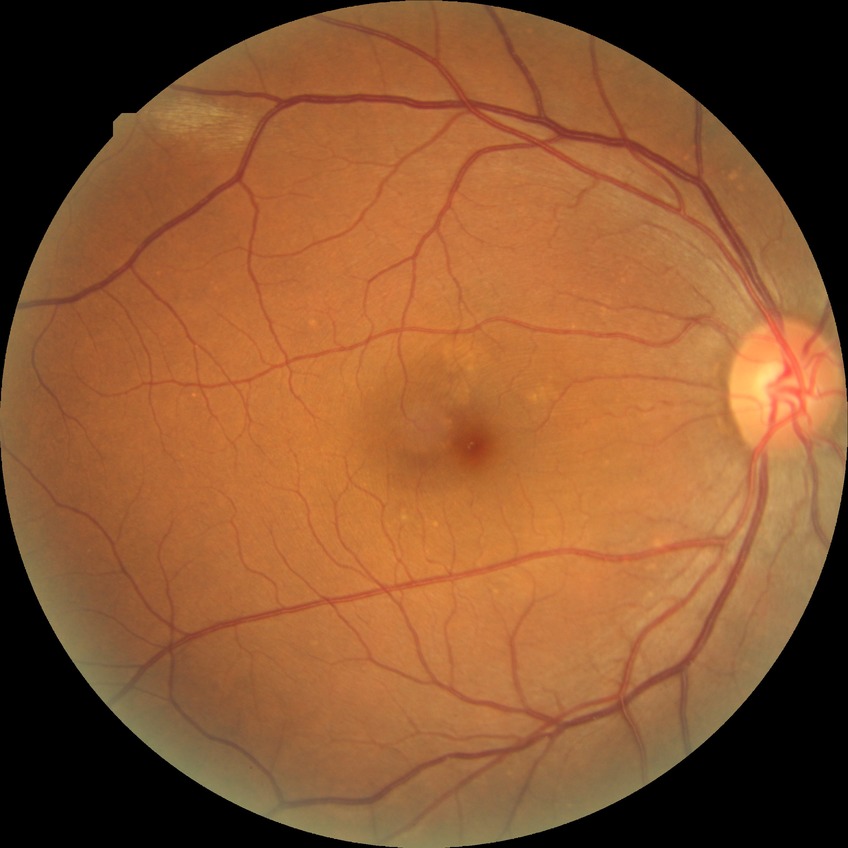
{
  "davis_grade": "NDR"
}